2352 x 1568 pixels. 45° field of view. CFP
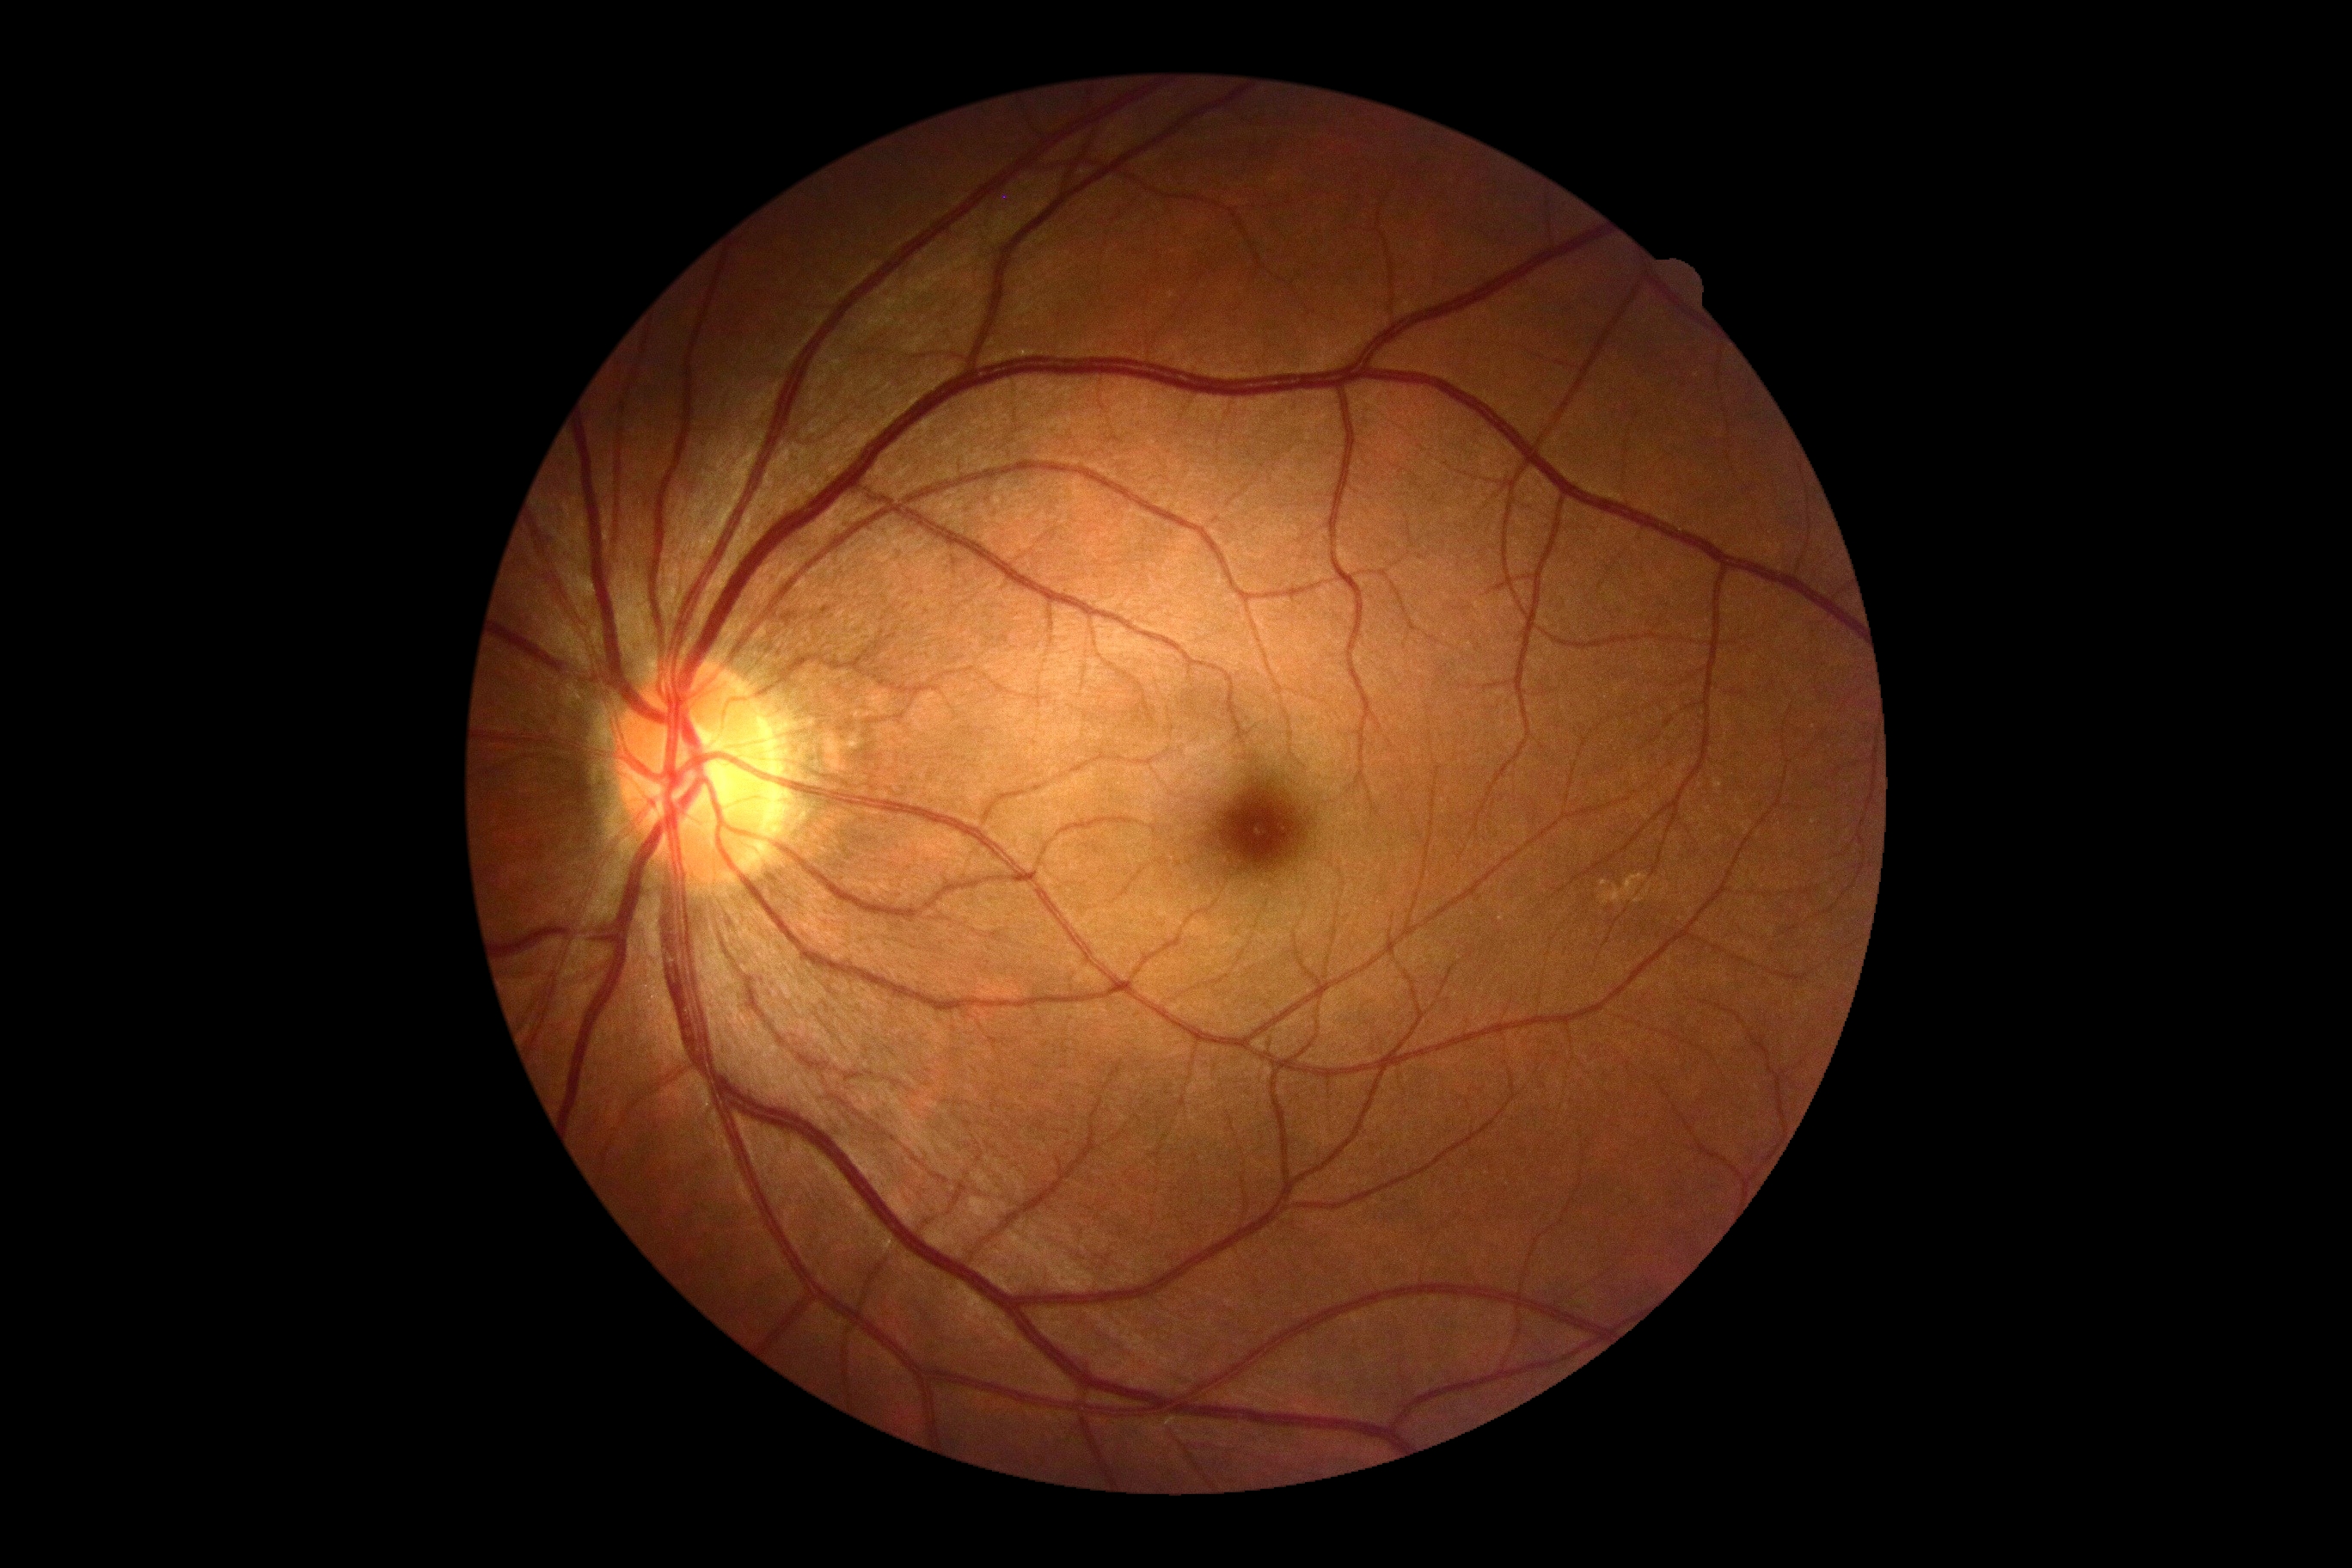 DR grade: 0 (no apparent retinopathy).